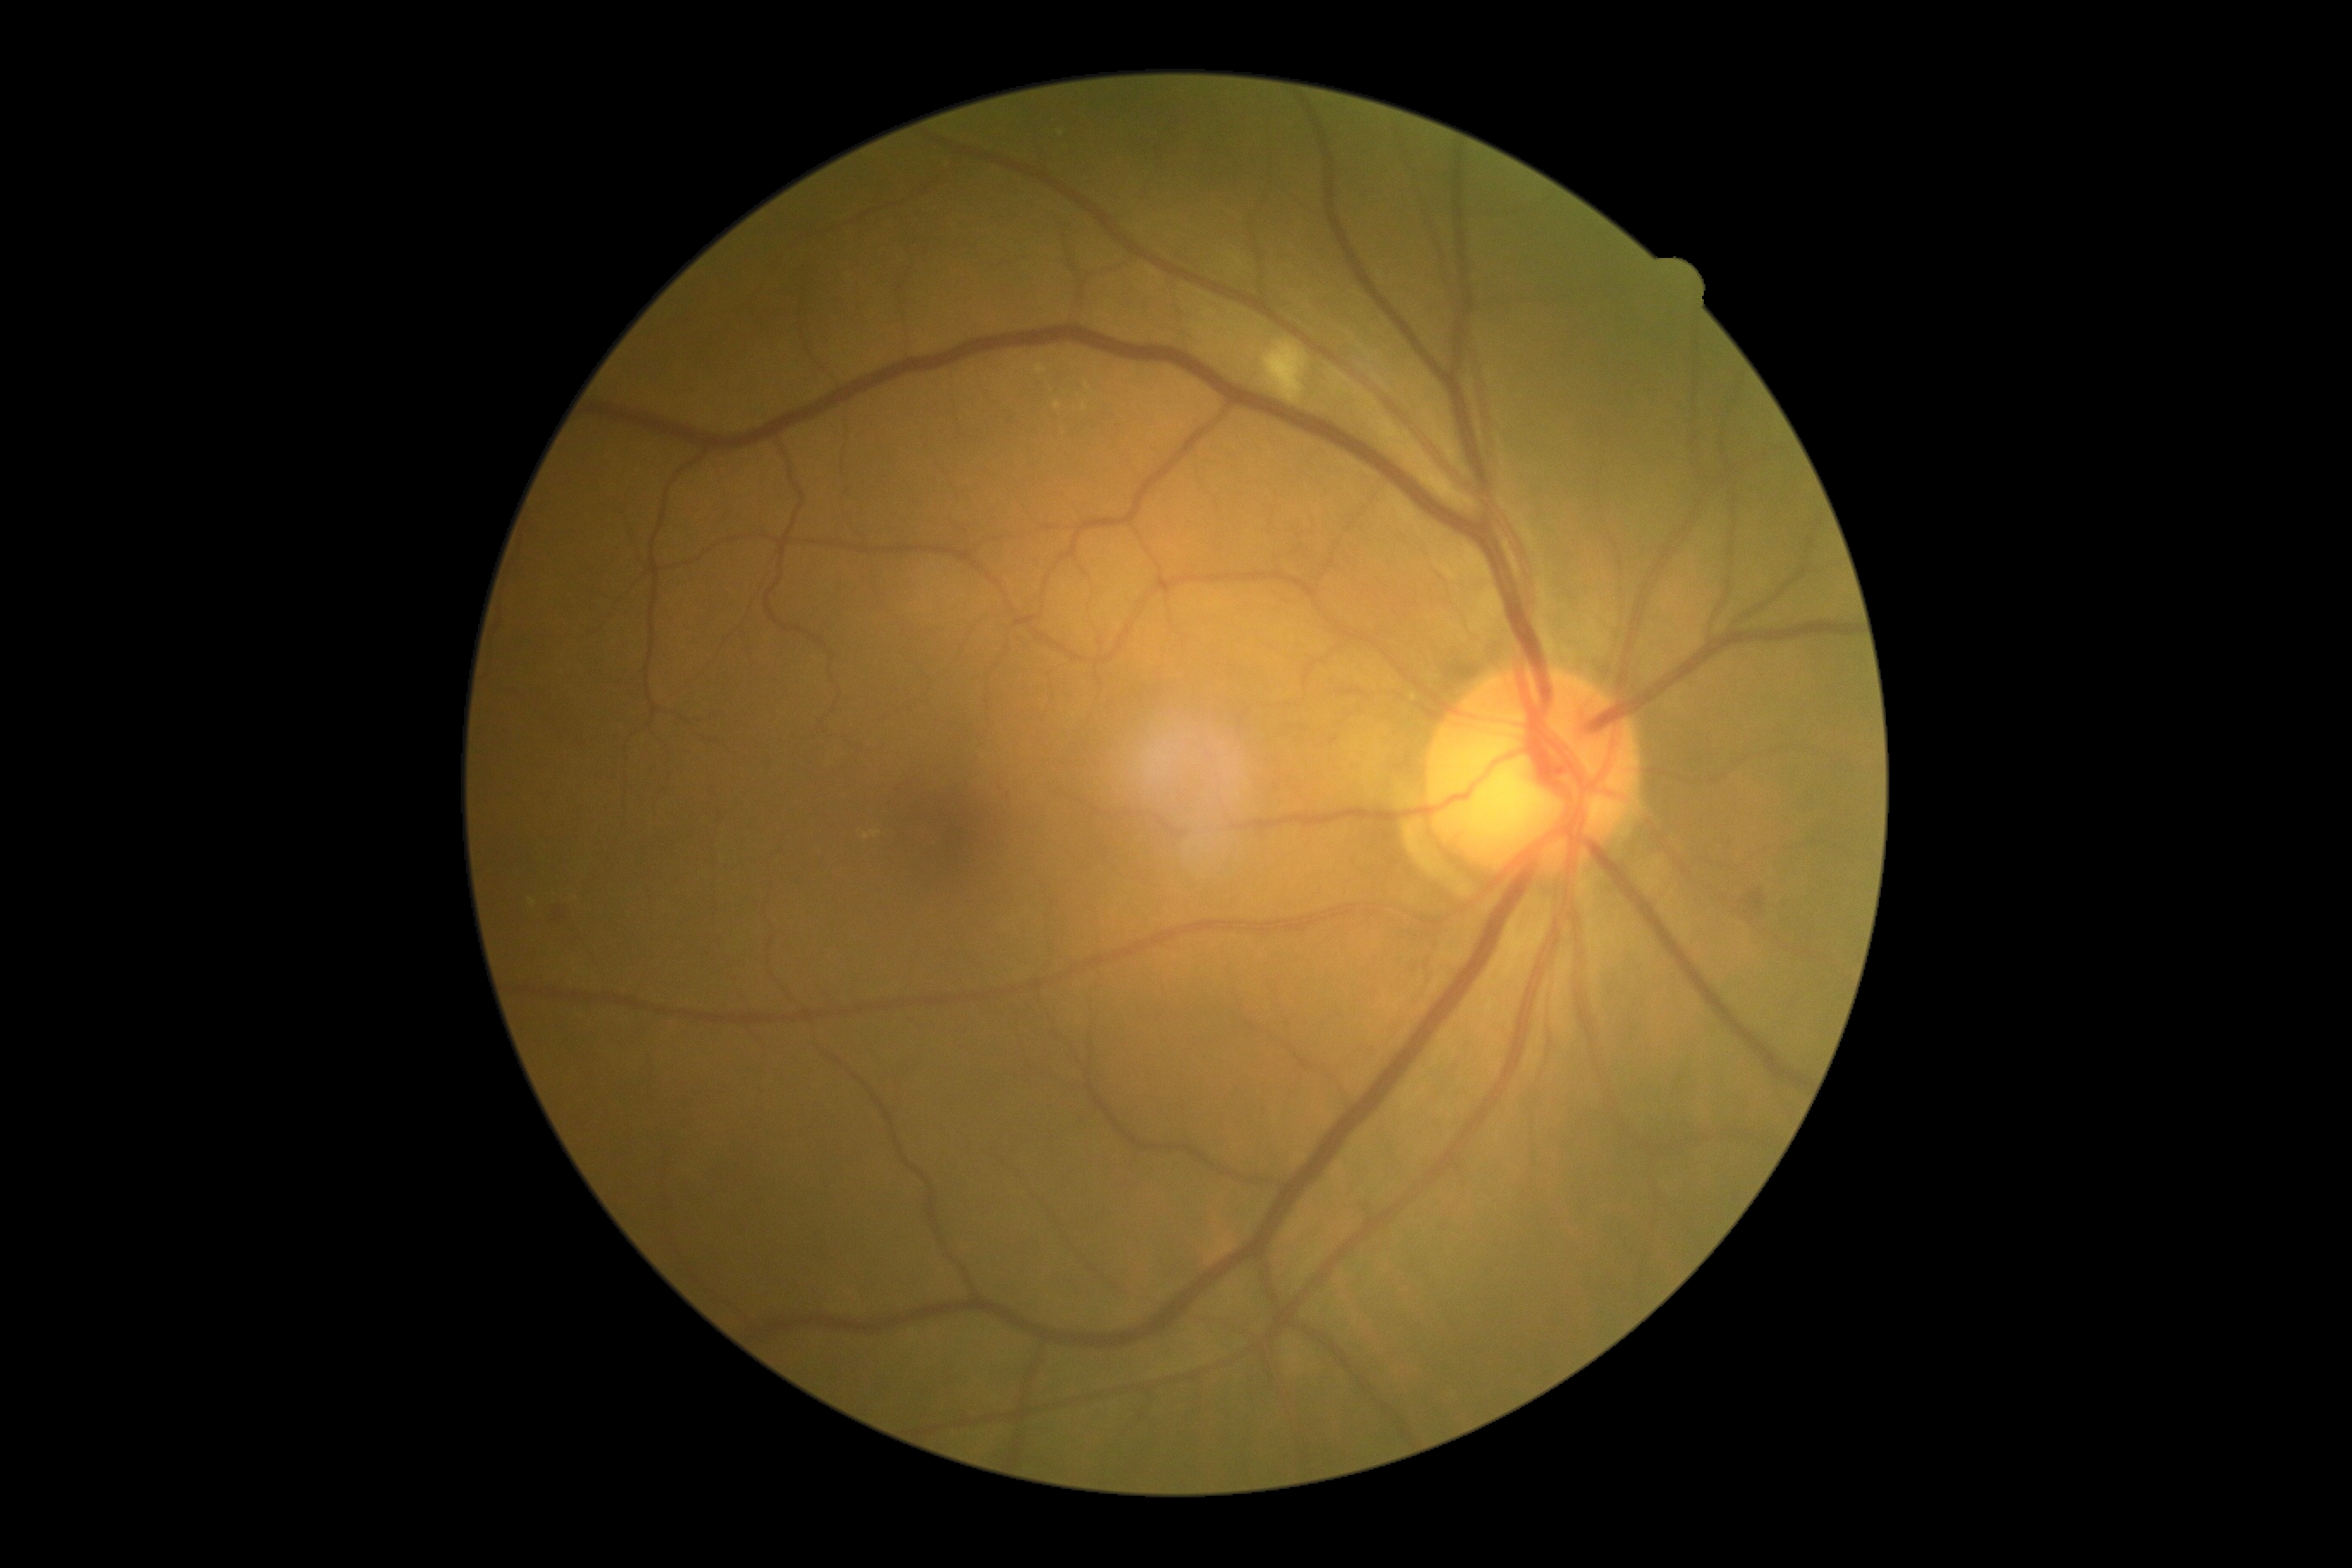 DR class: non-proliferative diabetic retinopathy. DR severity is grade 2.